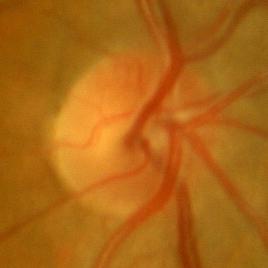
This optic disc photograph shows no glaucomatous findings.